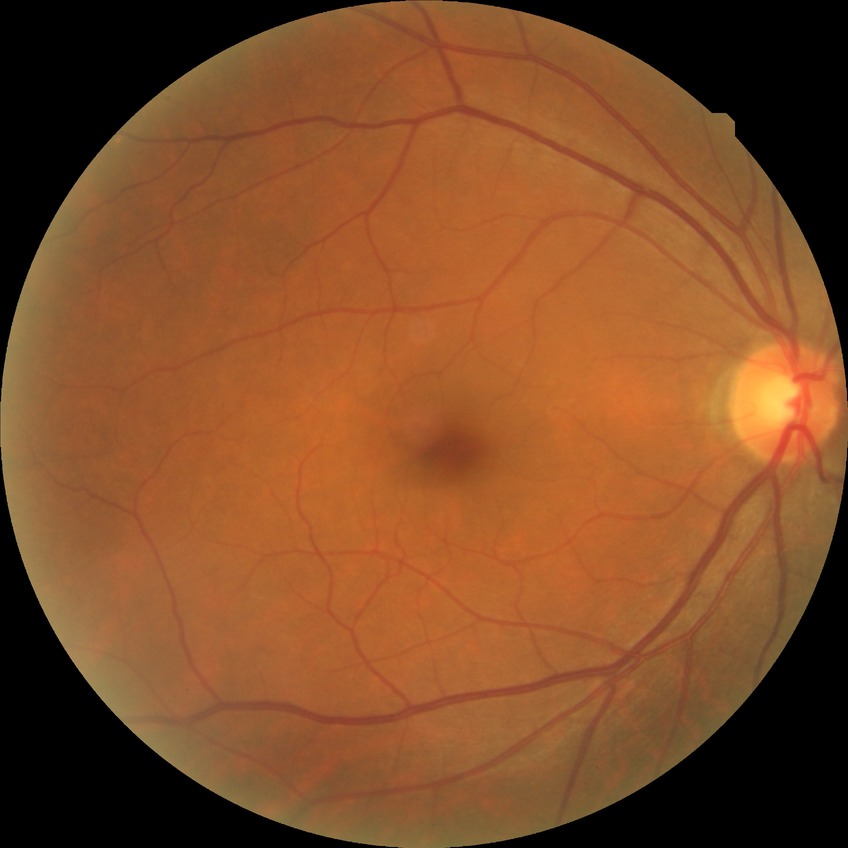 Diabetic retinopathy (DR): NDR (no diabetic retinopathy).